Color fundus image — 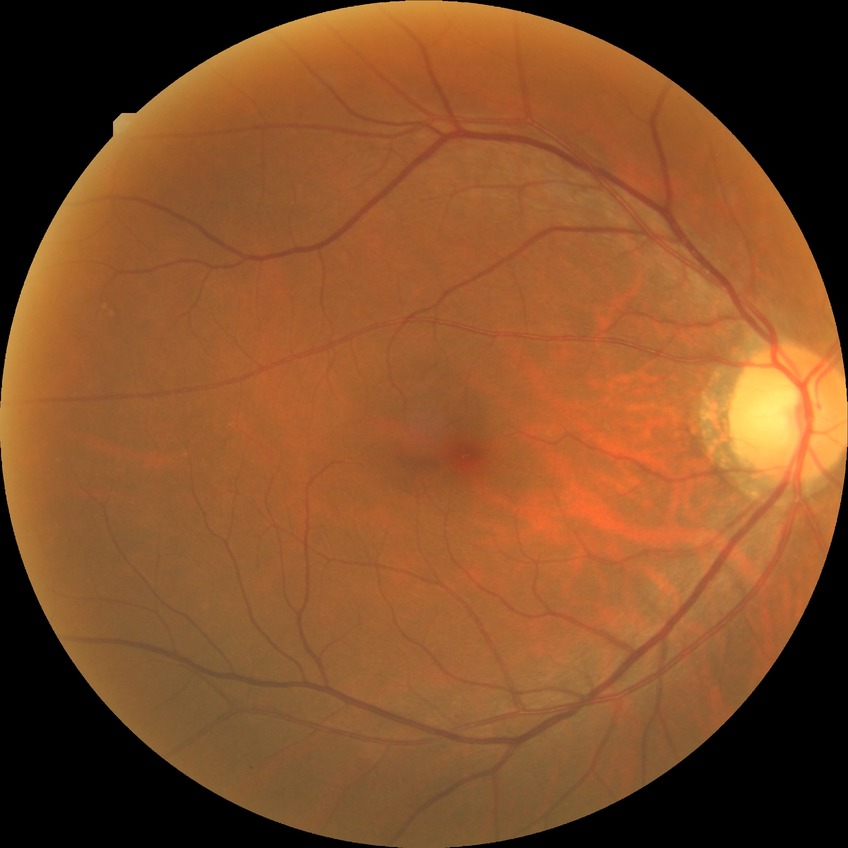 Diabetic retinopathy (DR) is NDR (no diabetic retinopathy).